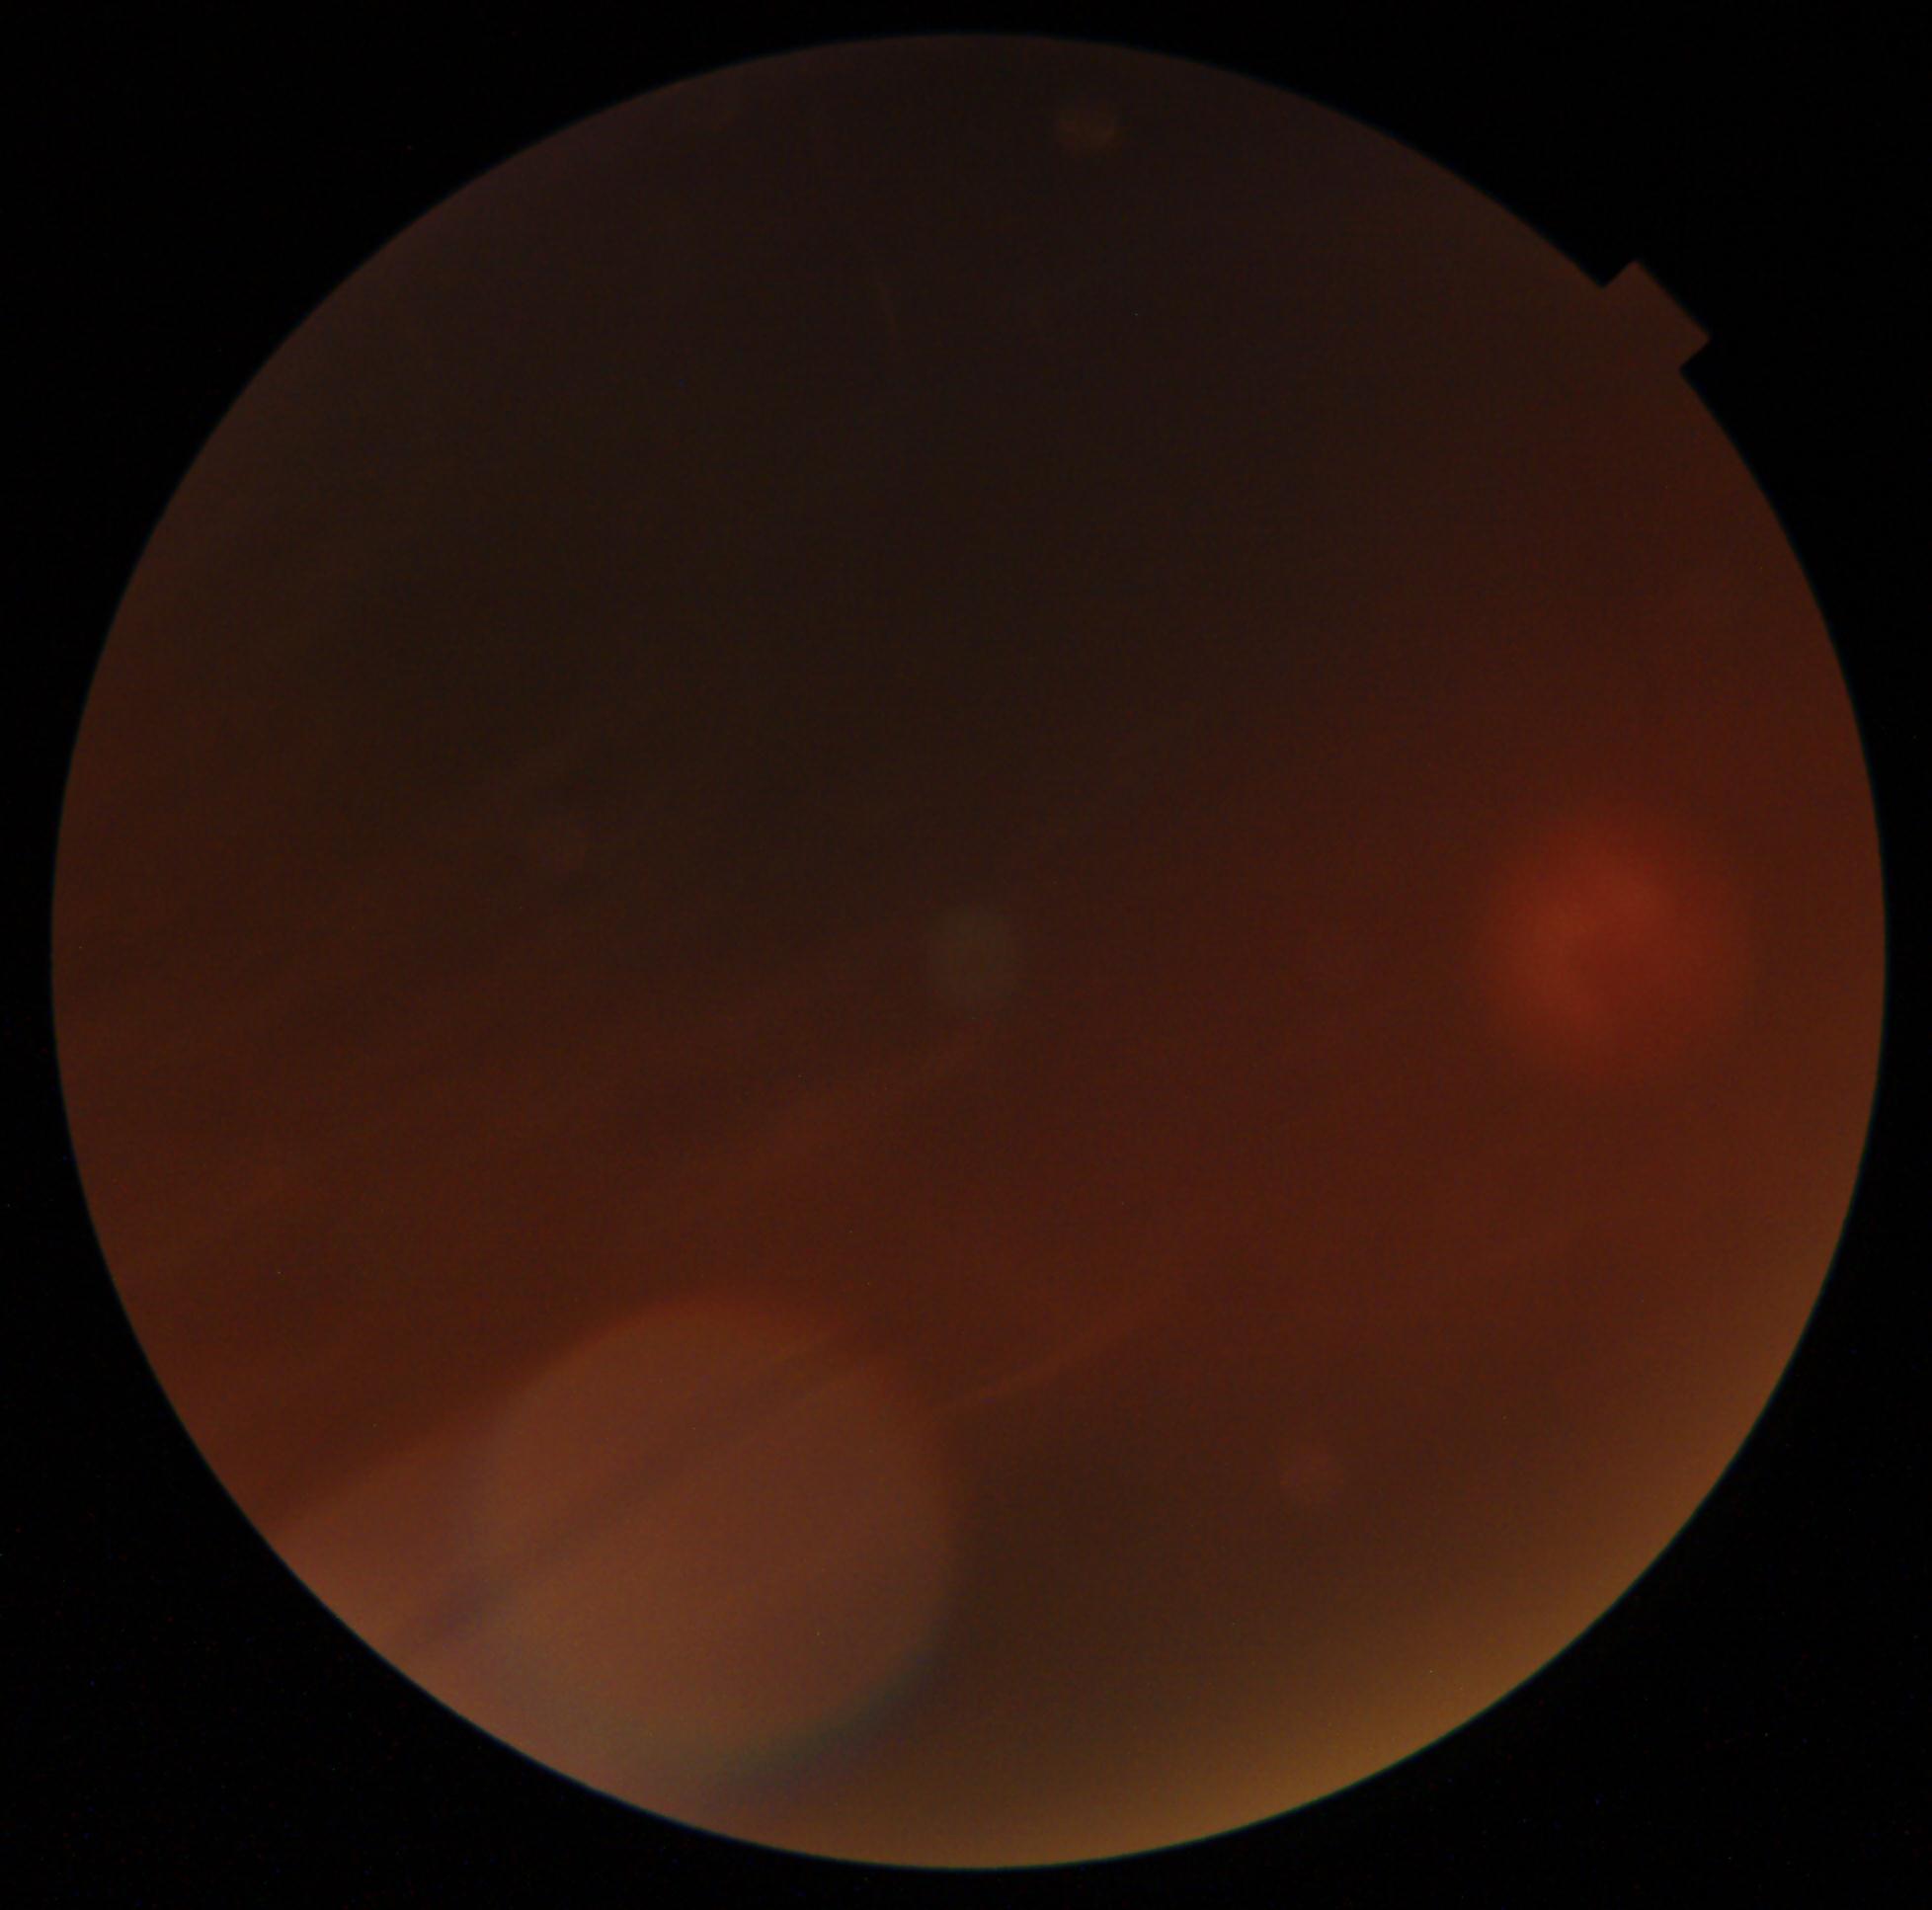
Image quality is insufficient for diabetic retinopathy assessment. Diabetic retinopathy grade: ungradable due to poor image quality.